Topcon TRC-50DX:
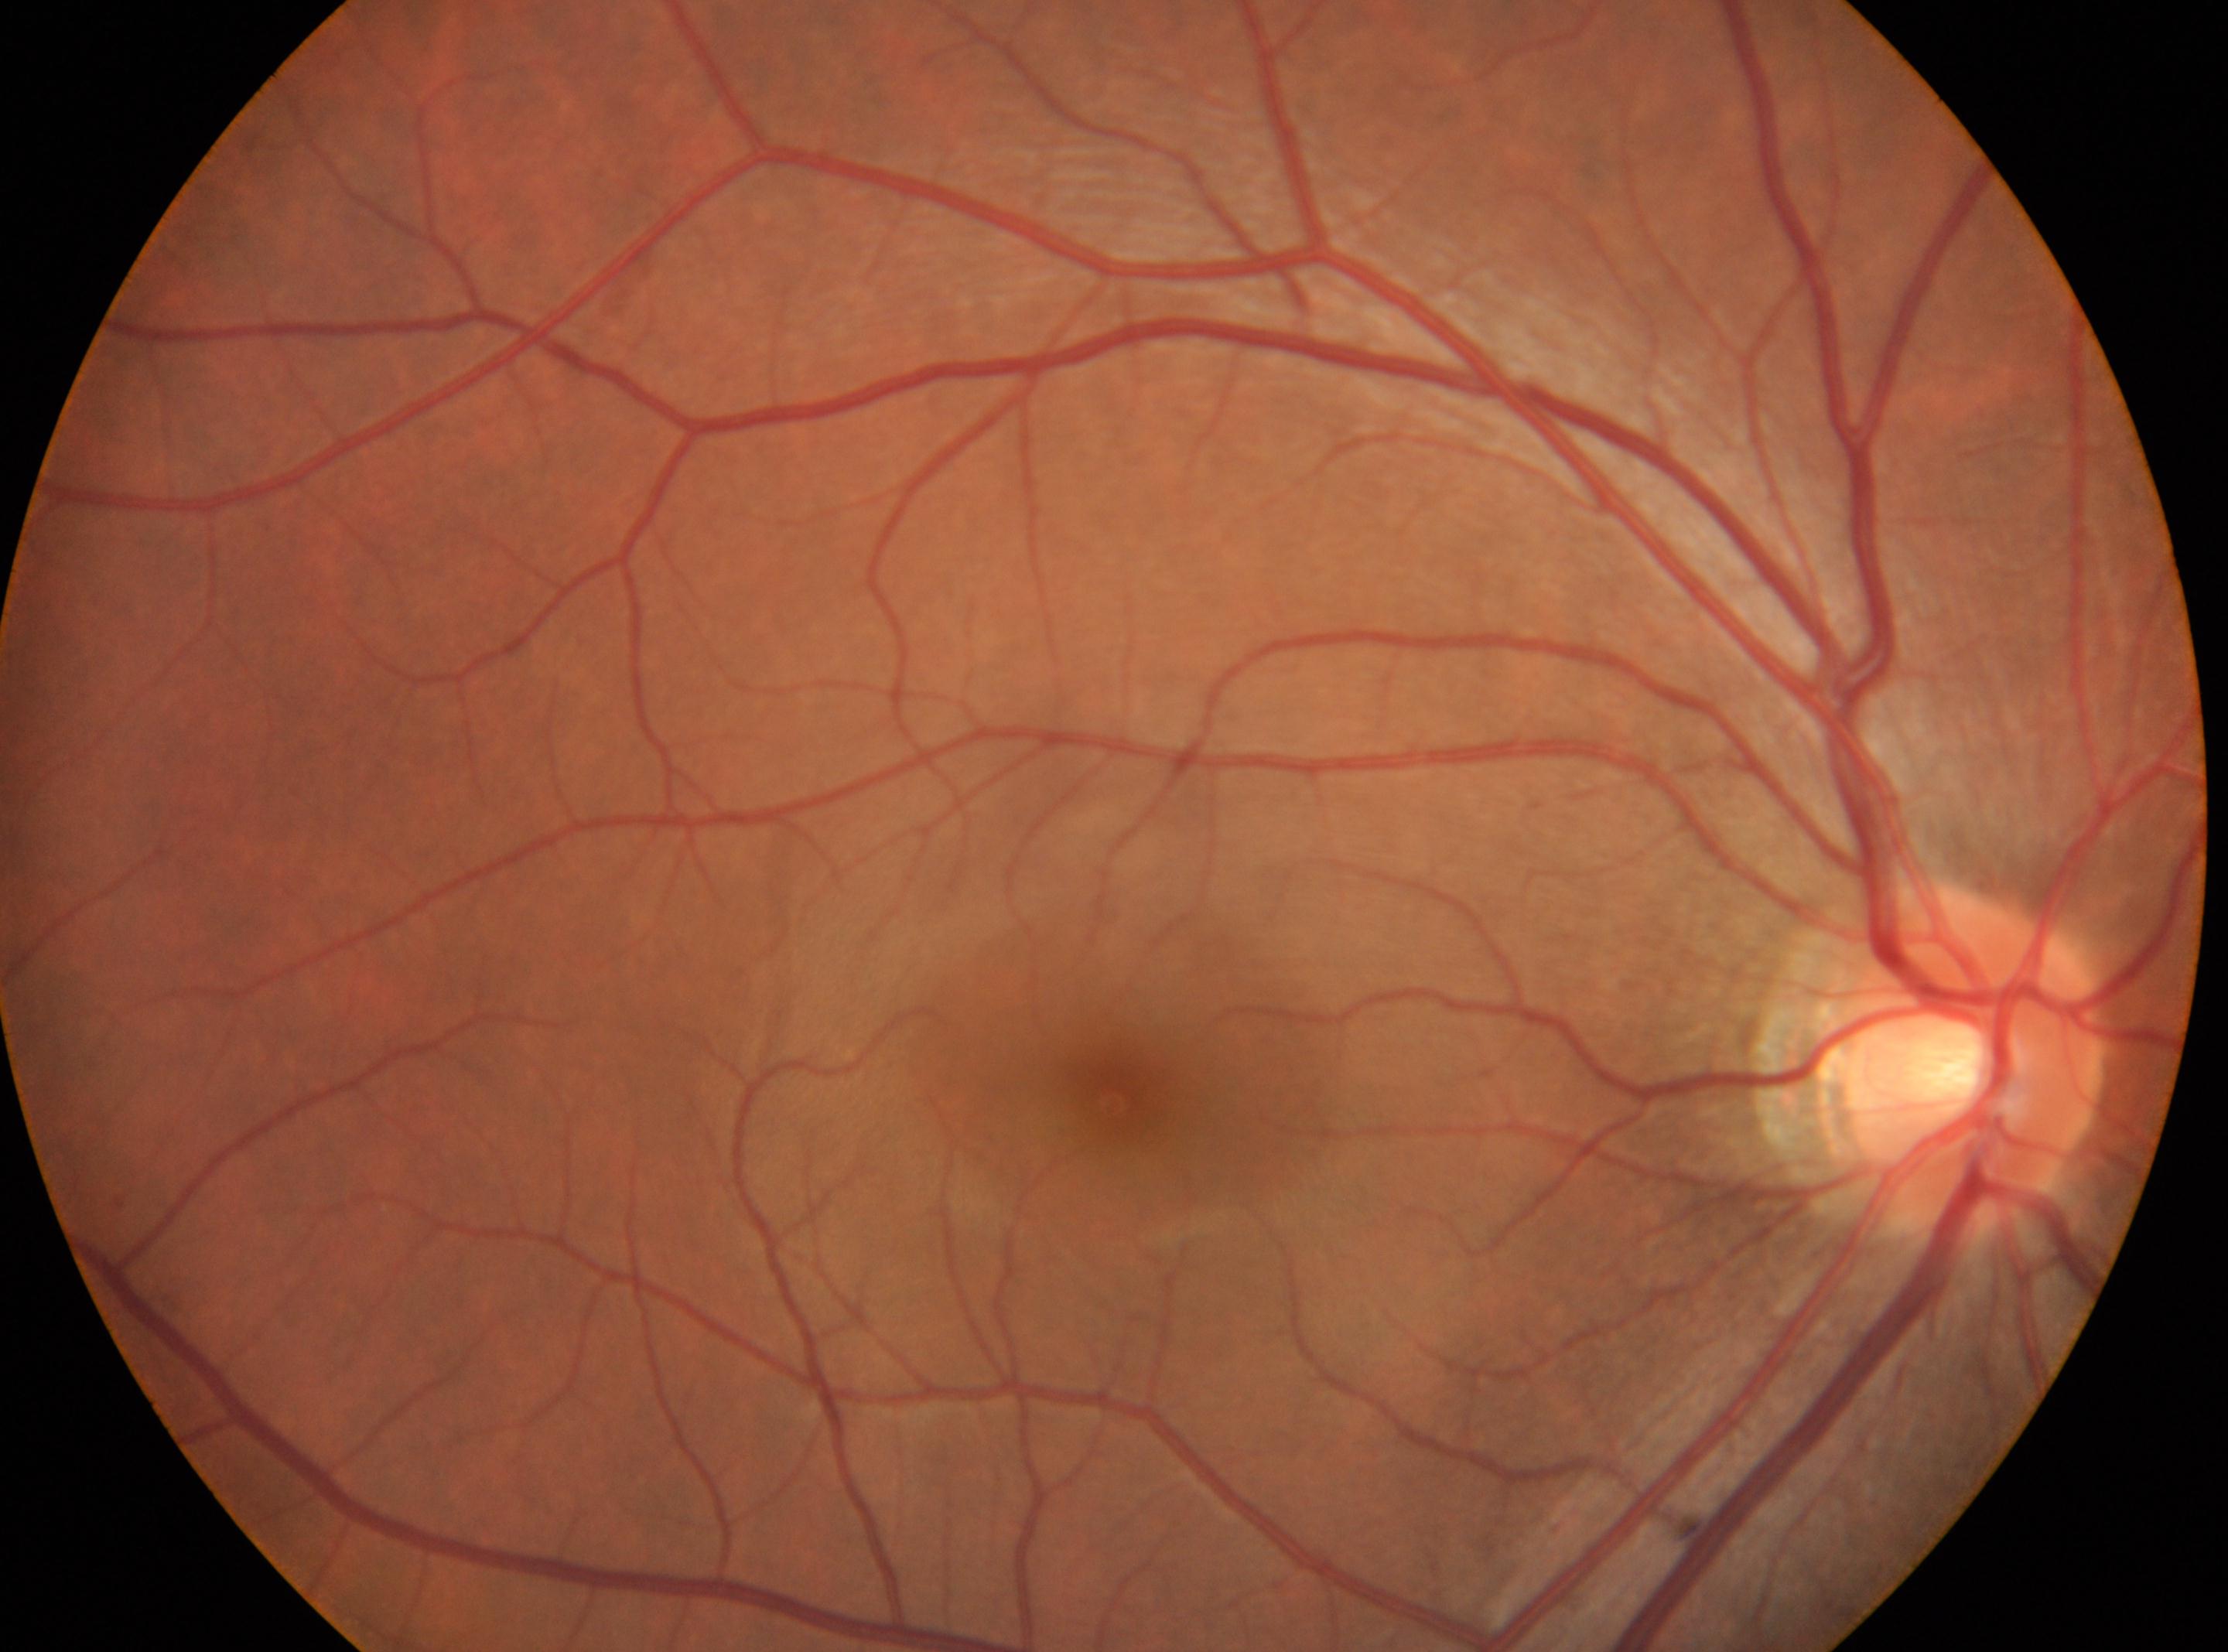

{"fovea": "1119px, 1094px", "dr_grade": "no apparent diabetic retinopathy (grade 0)", "optic_disc": "1971px, 1058px", "dr_impression": "No DR findings", "eye": "right"}